1932x1932px · pupil-dilated
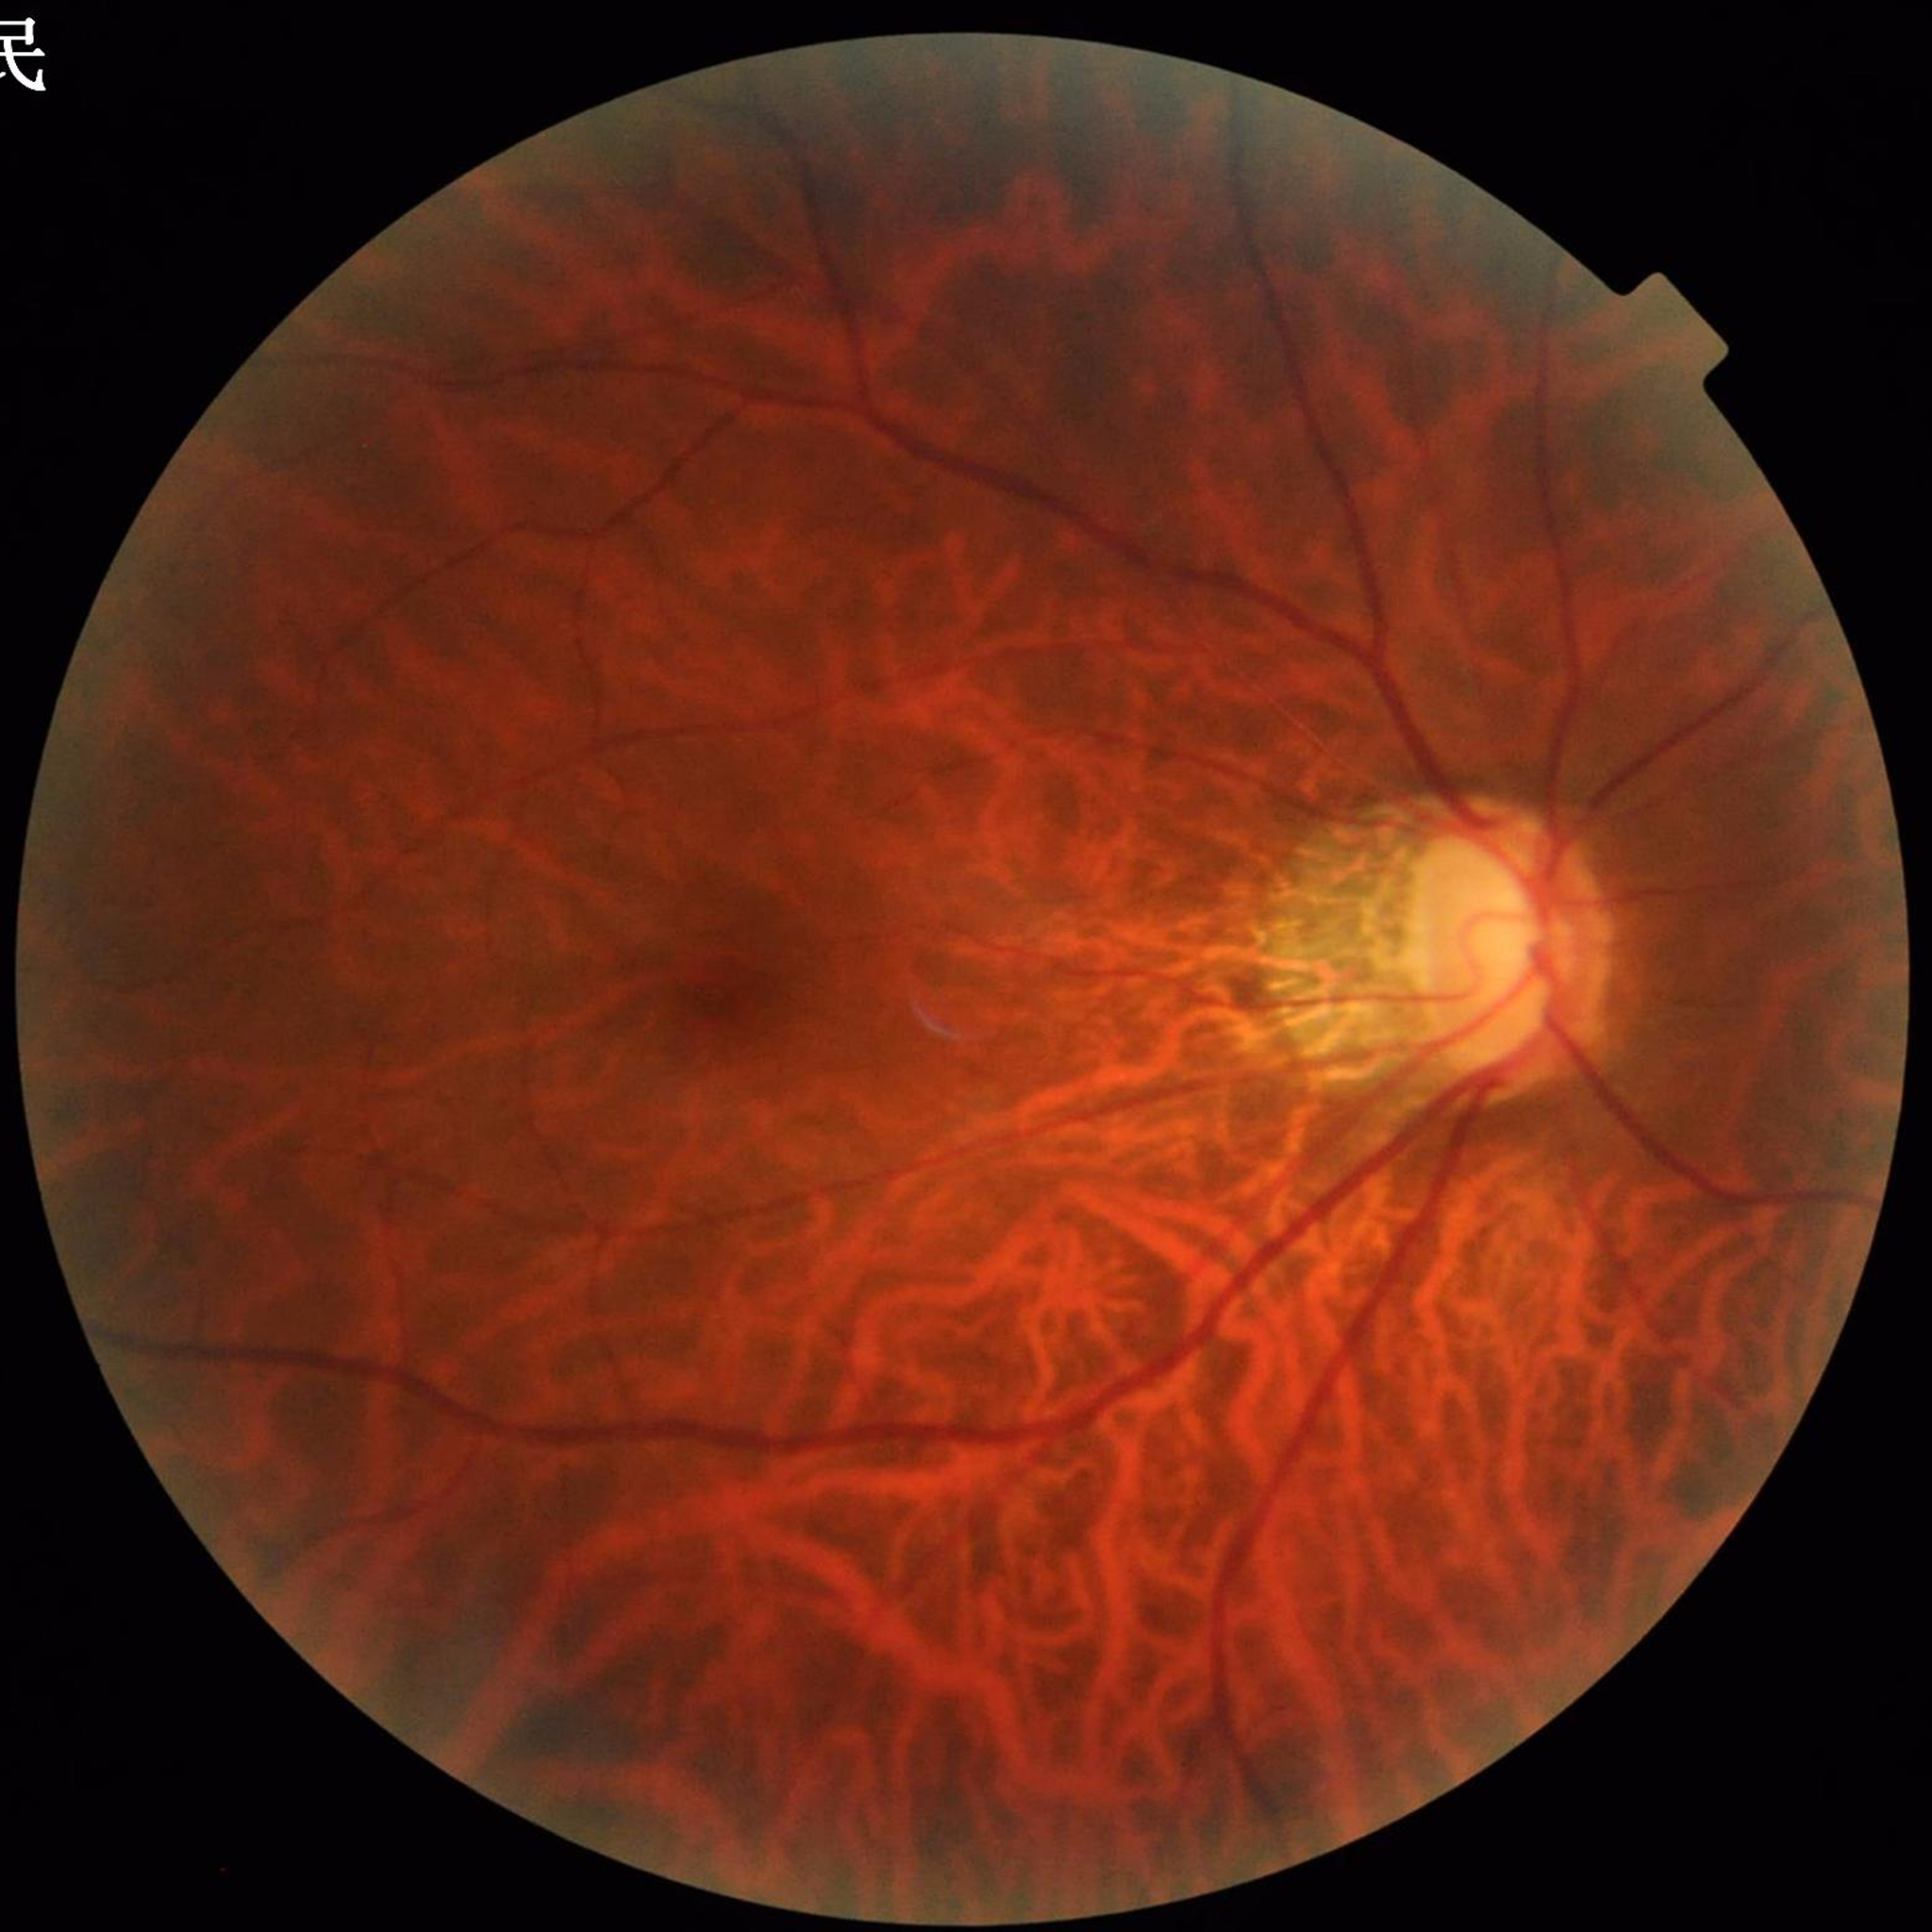

Diagnosis = glaucoma